Color fundus image.
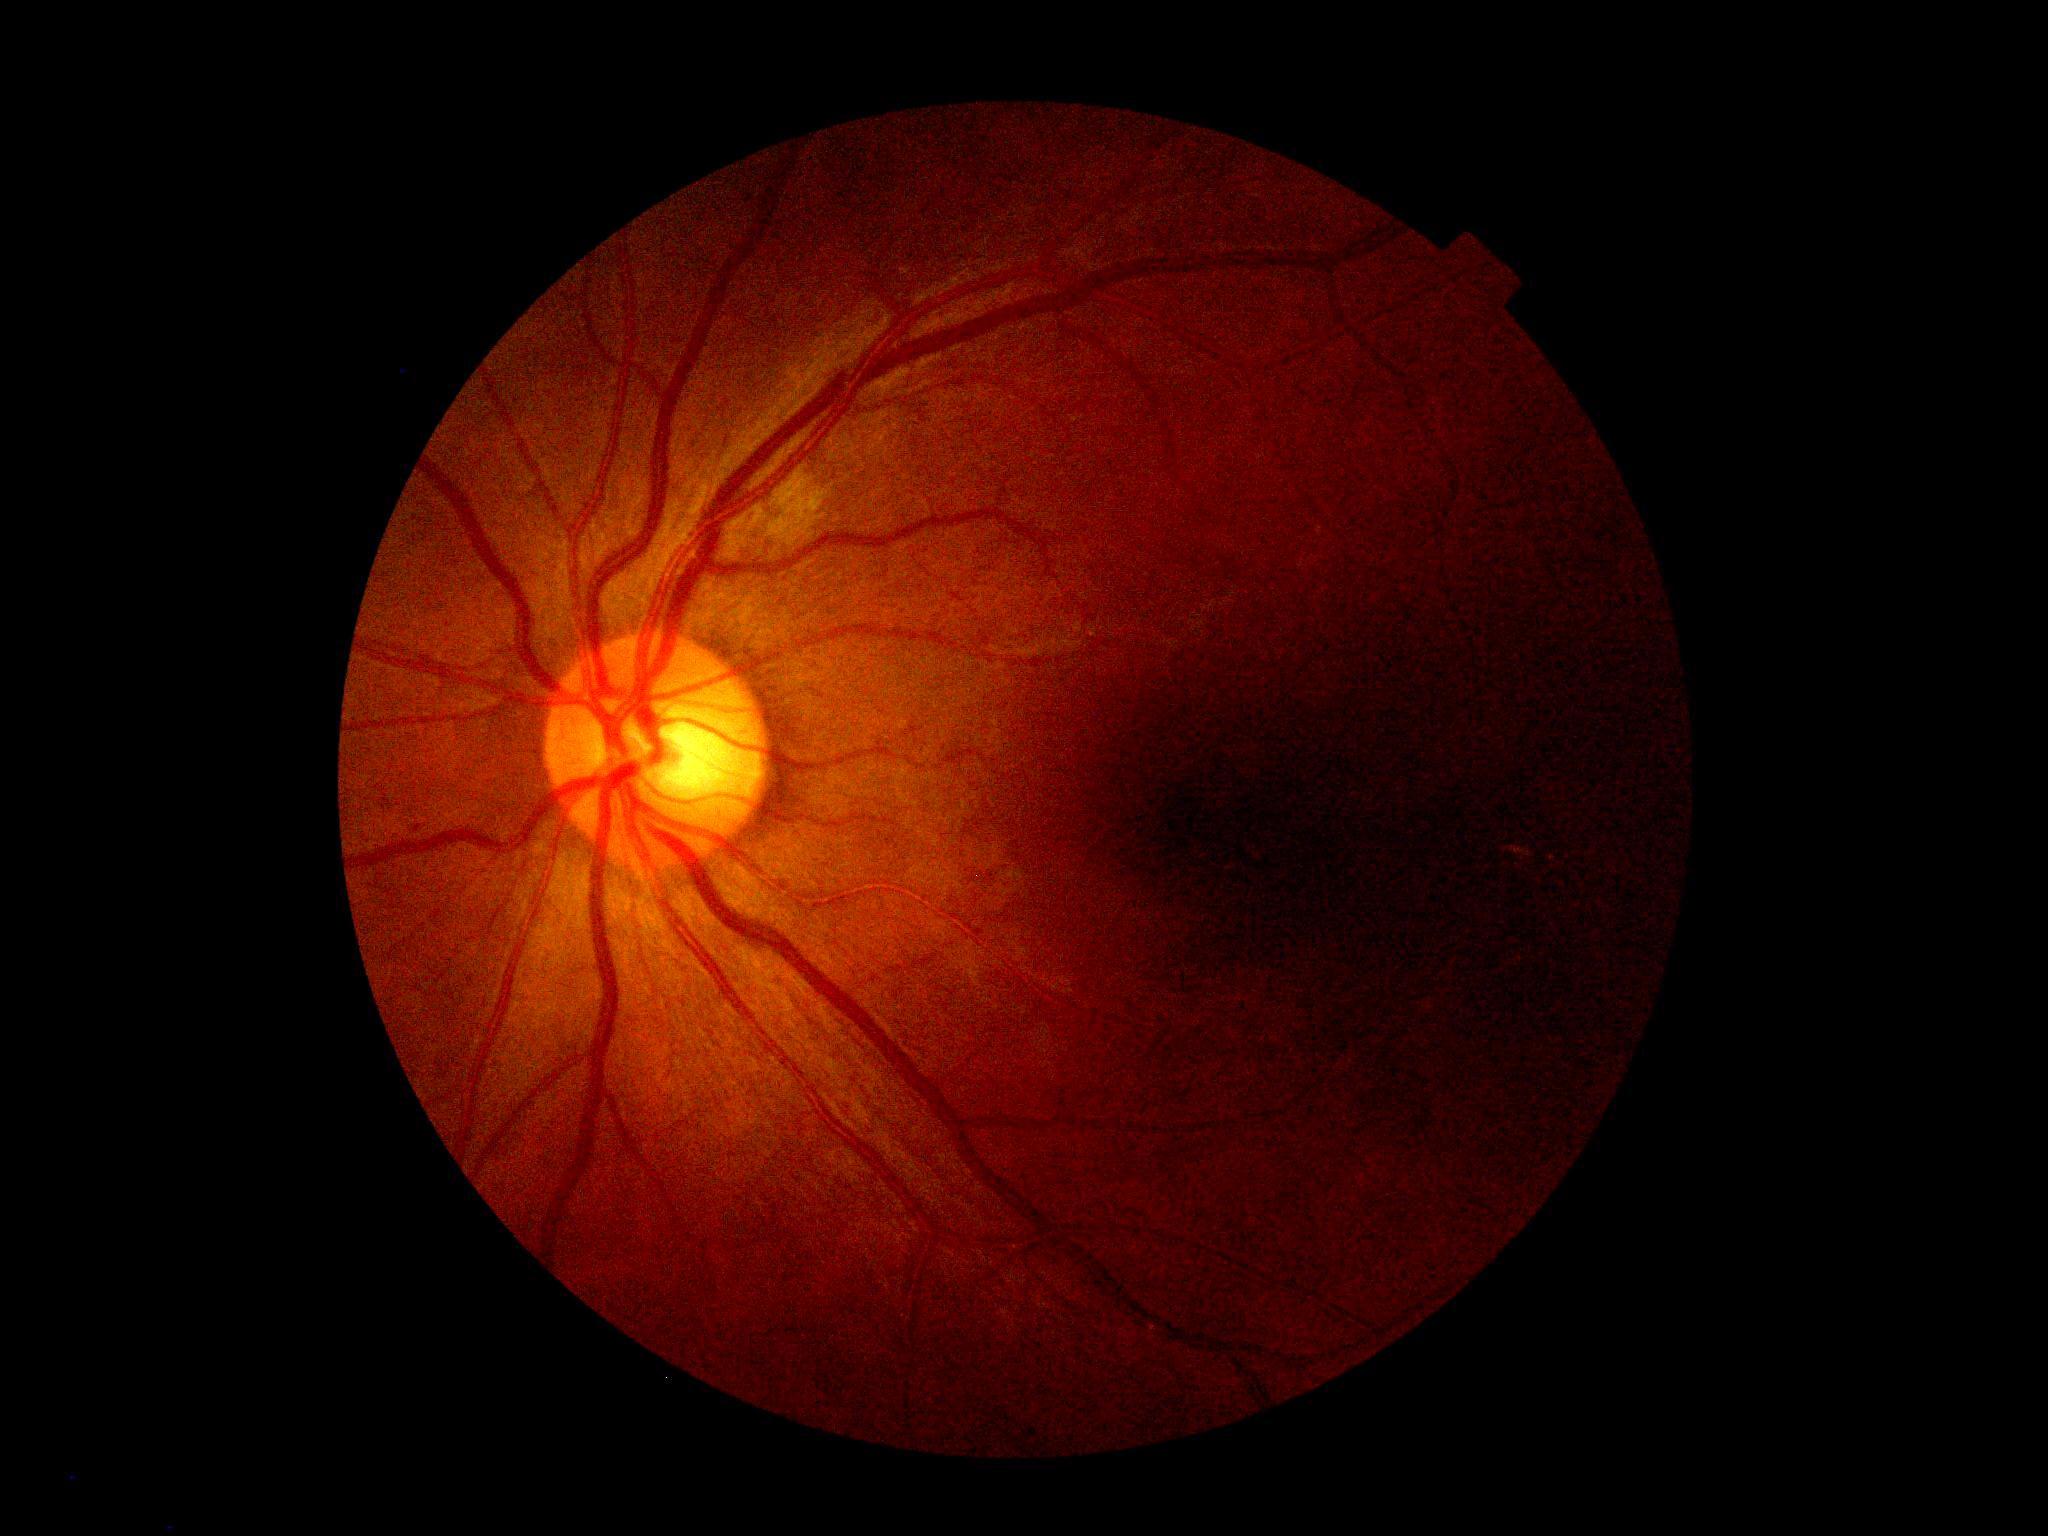
Diabetic retinopathy (DR): grade 2 (moderate NPDR).